Camera: NIDEK AFC-230; modified Davis grading: 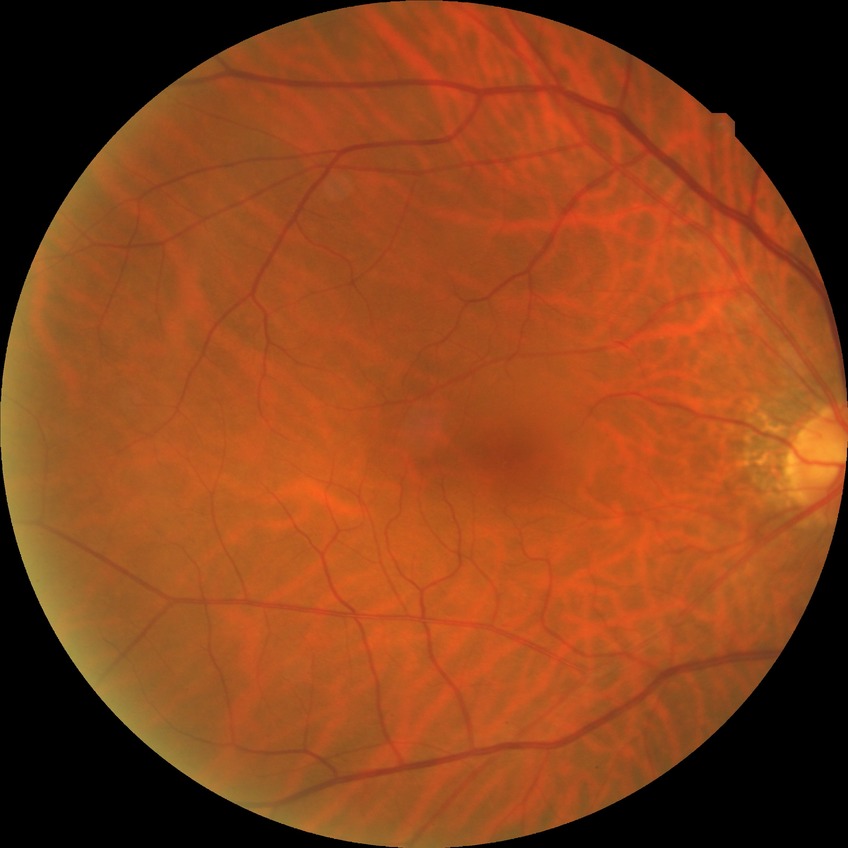
Retinopathy stage: no diabetic retinopathy.